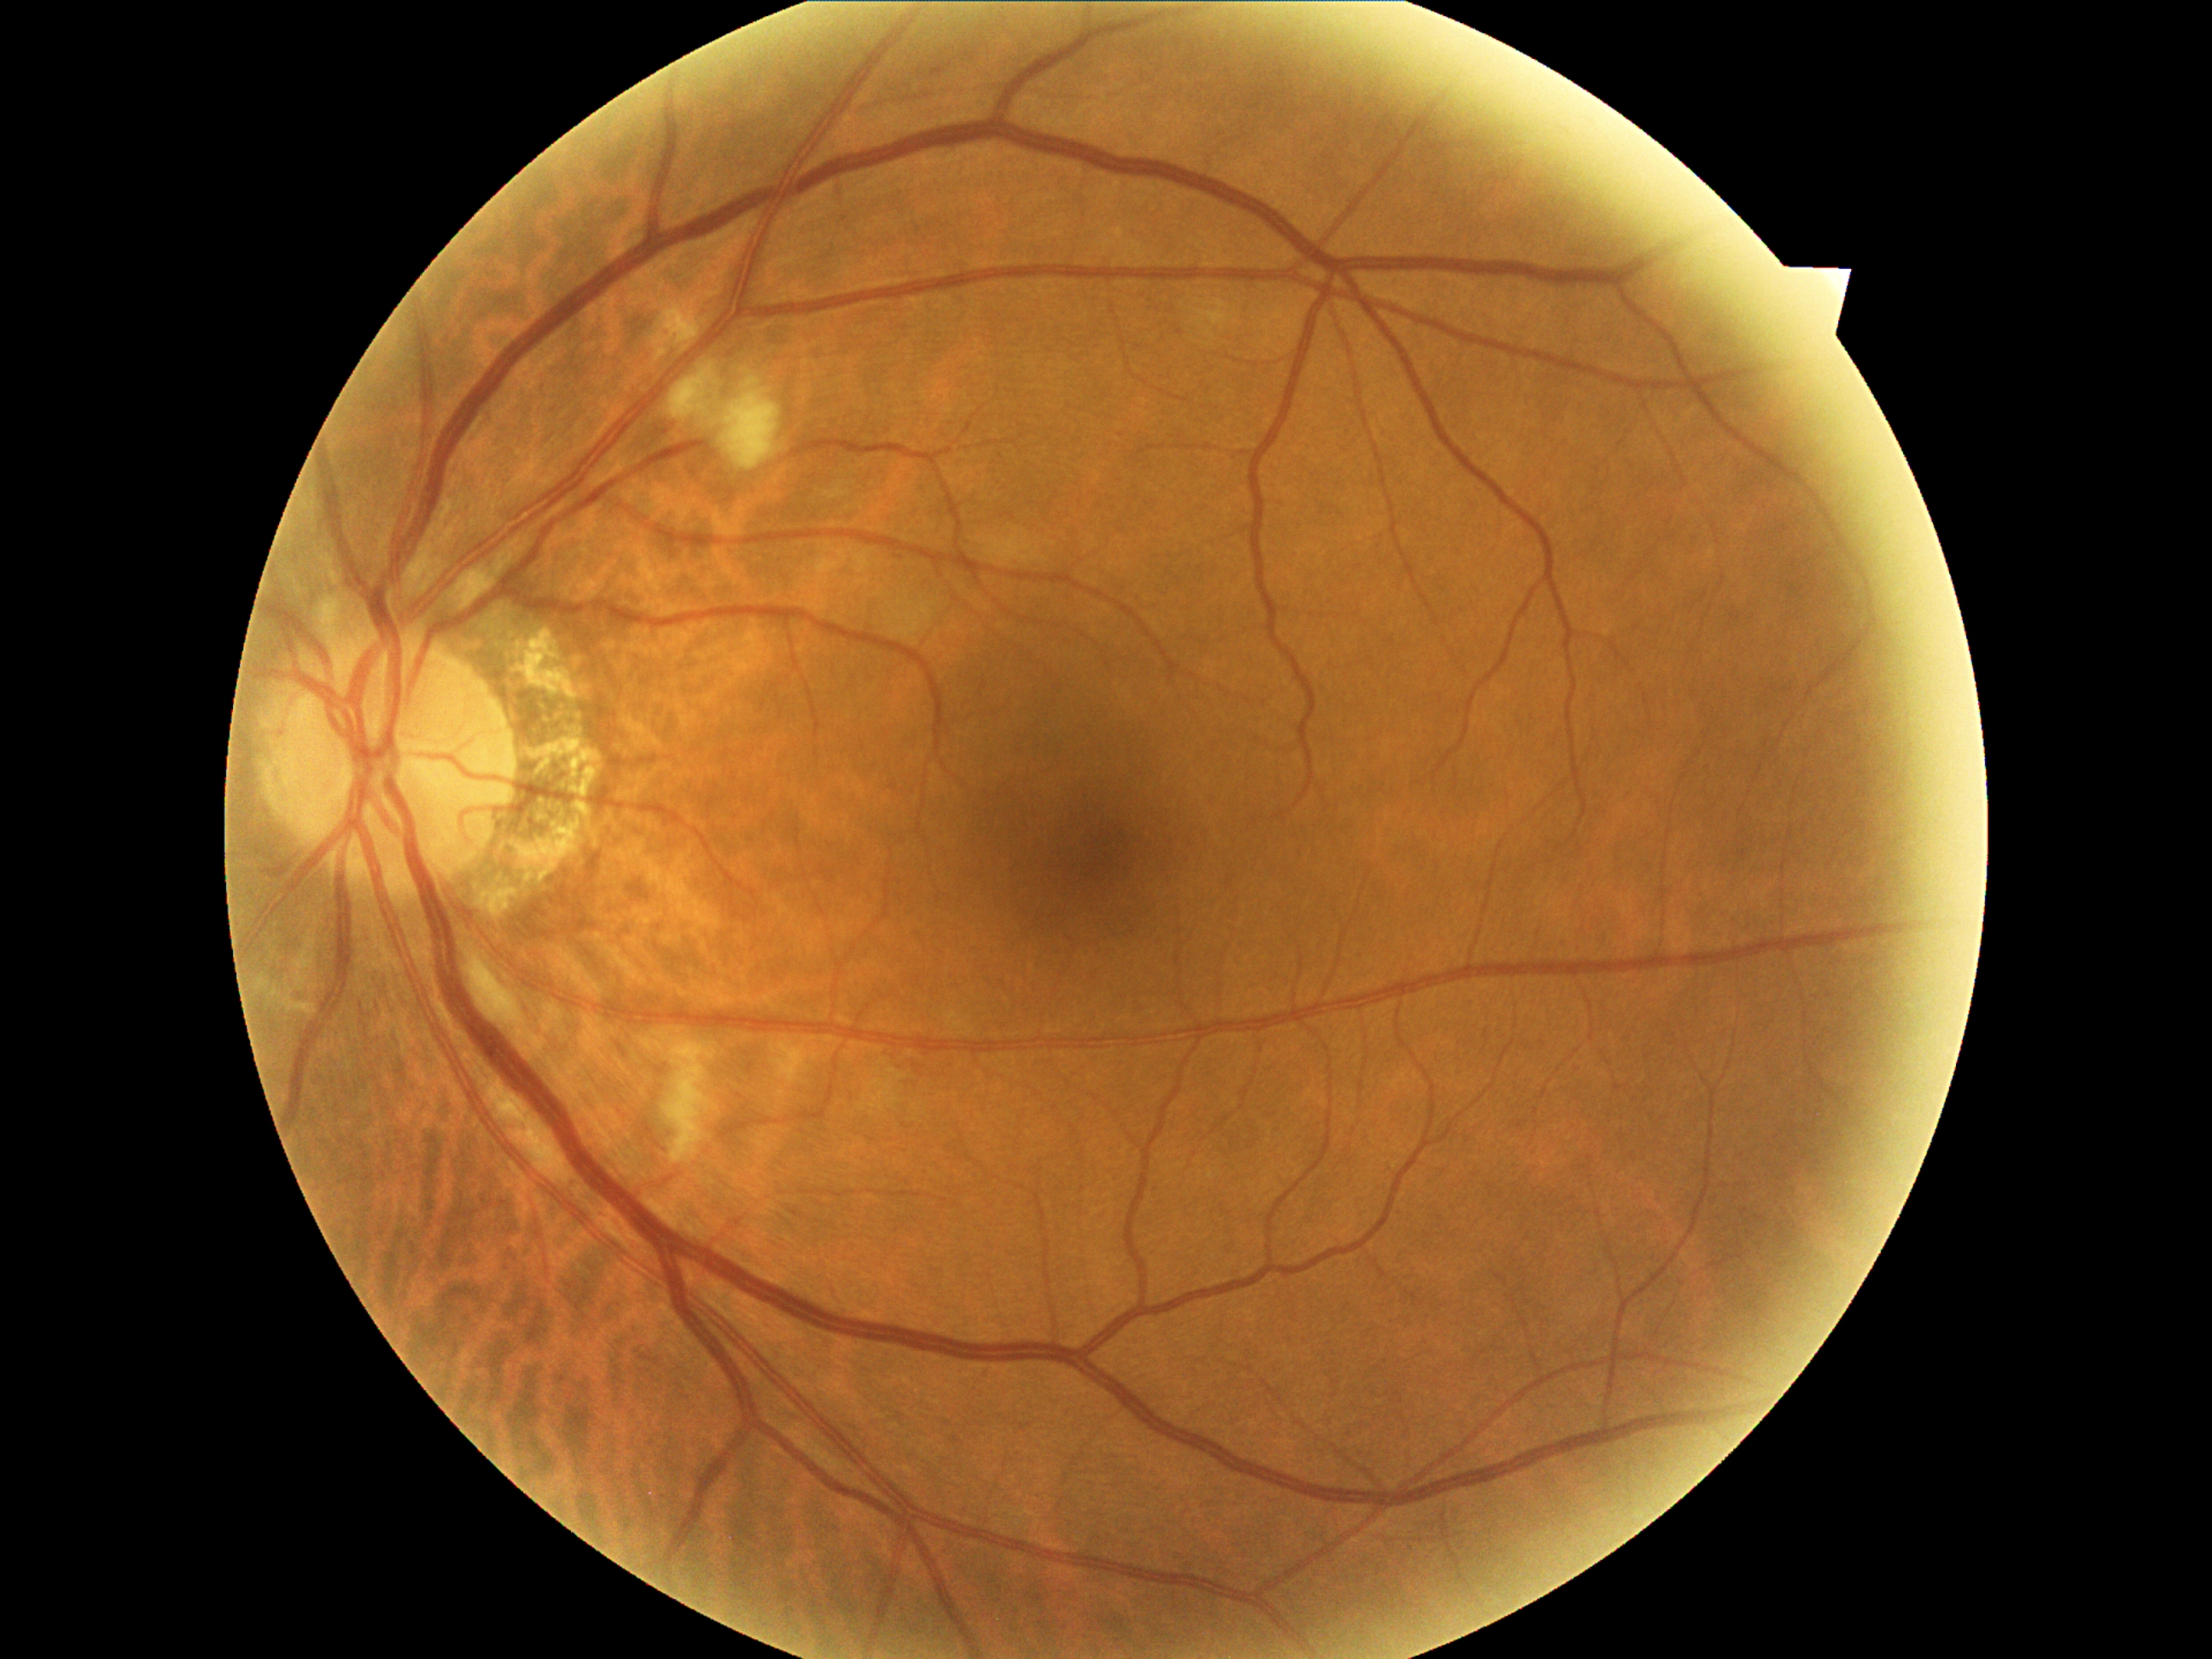

DR class: non-proliferative diabetic retinopathy.
Diabetic retinopathy grade is 2.